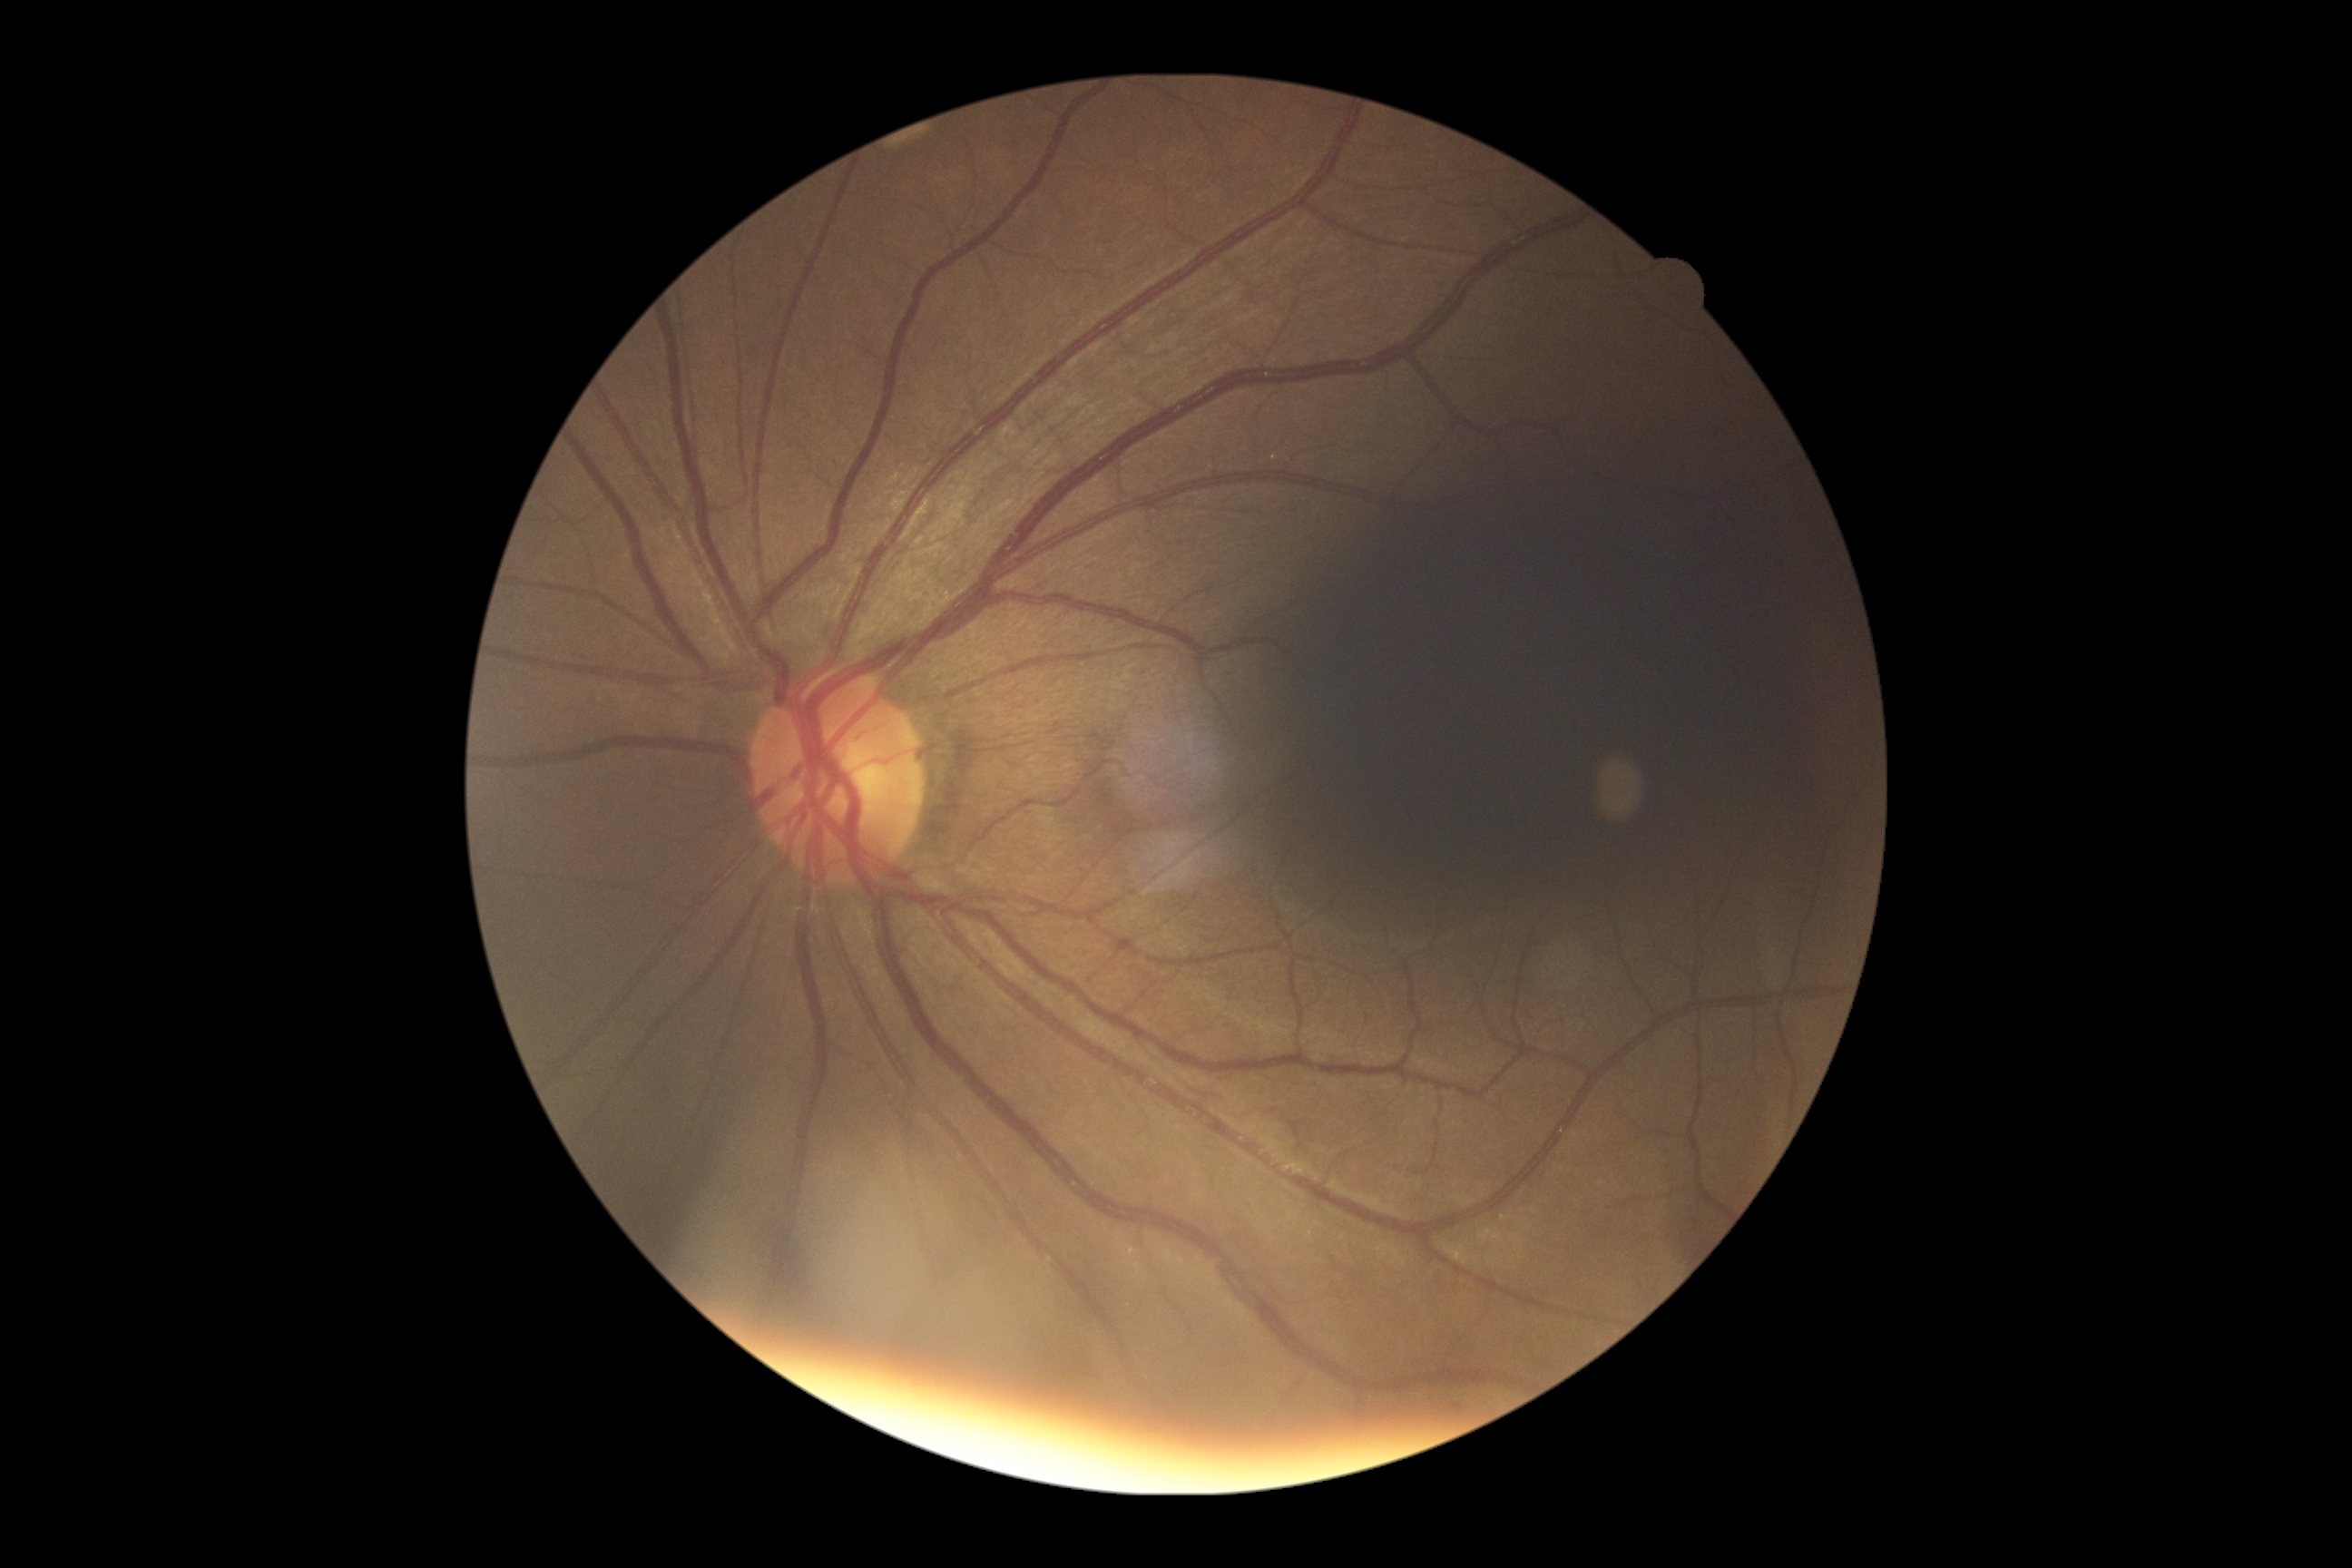   dr_grade: 0/4